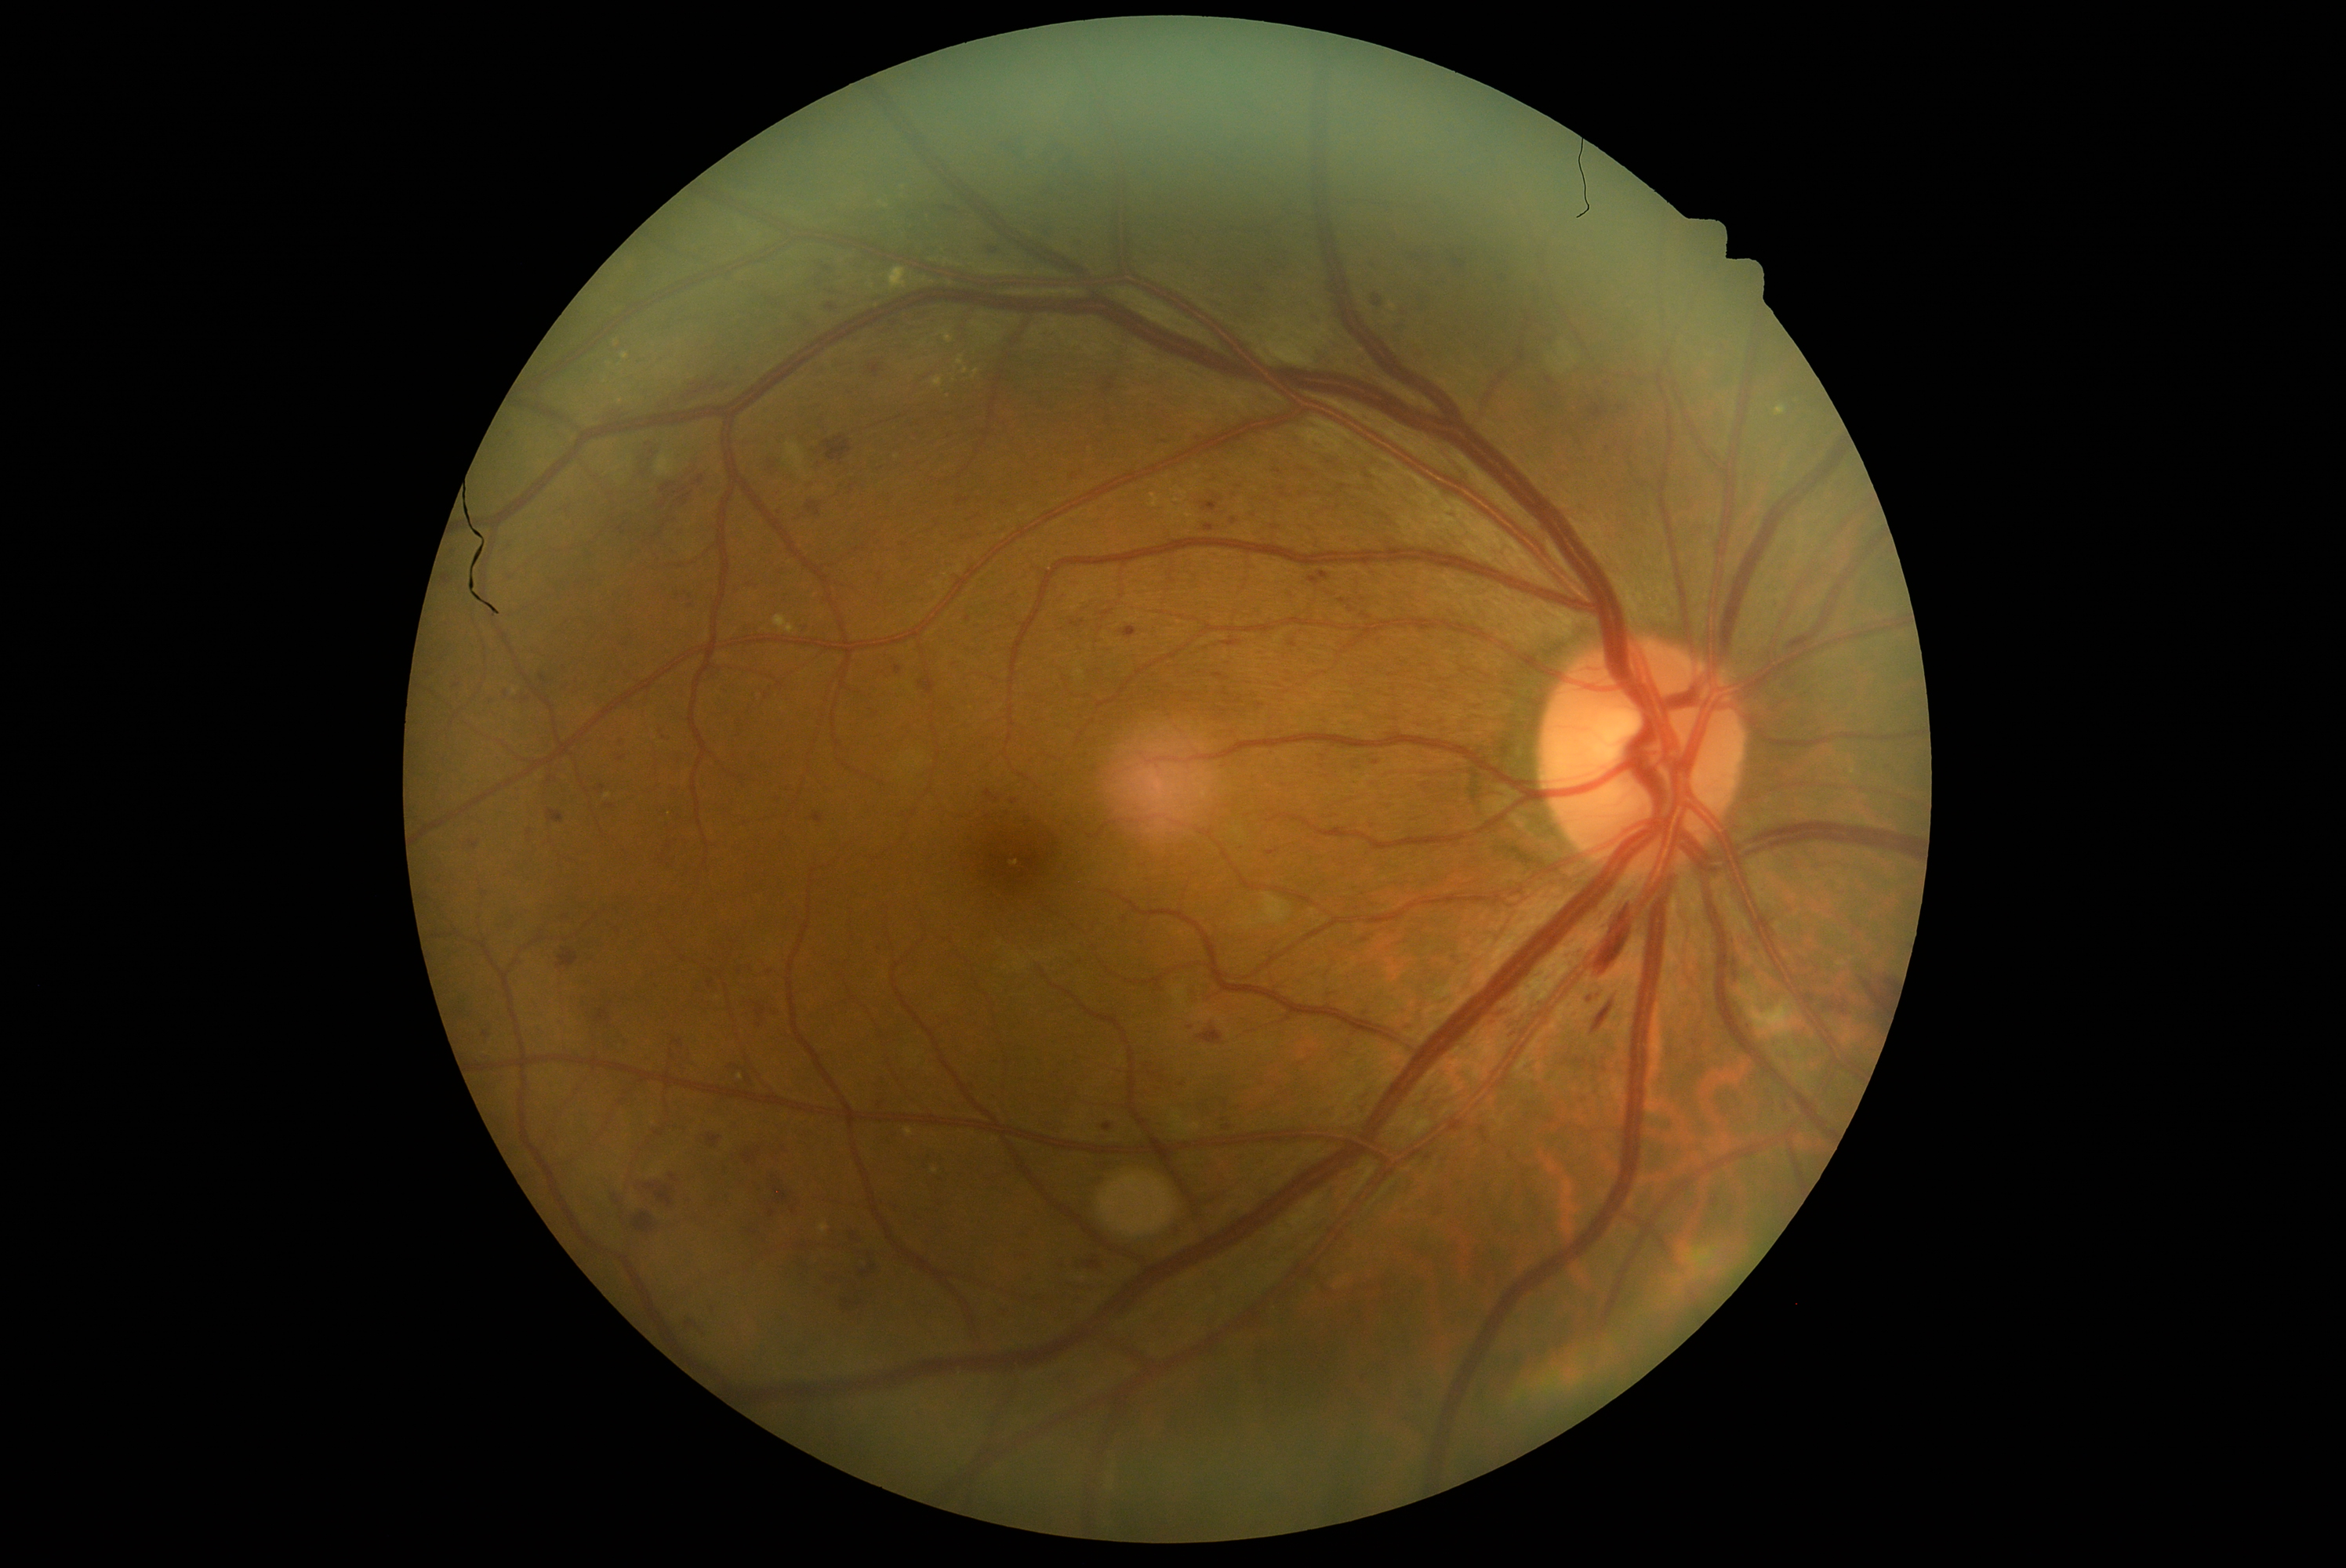
DR: grade 3 (severe NPDR) — more than 20 intraretinal hemorrhages in each of 4 quadrants, definite venous beading in 2 or more quadrants, or prominent intraretinal microvascular abnormalities in 1 or more quadrants, with no signs of proliferative retinopathy.
Disease class: non-proliferative diabetic retinopathy.